2352x1568px:
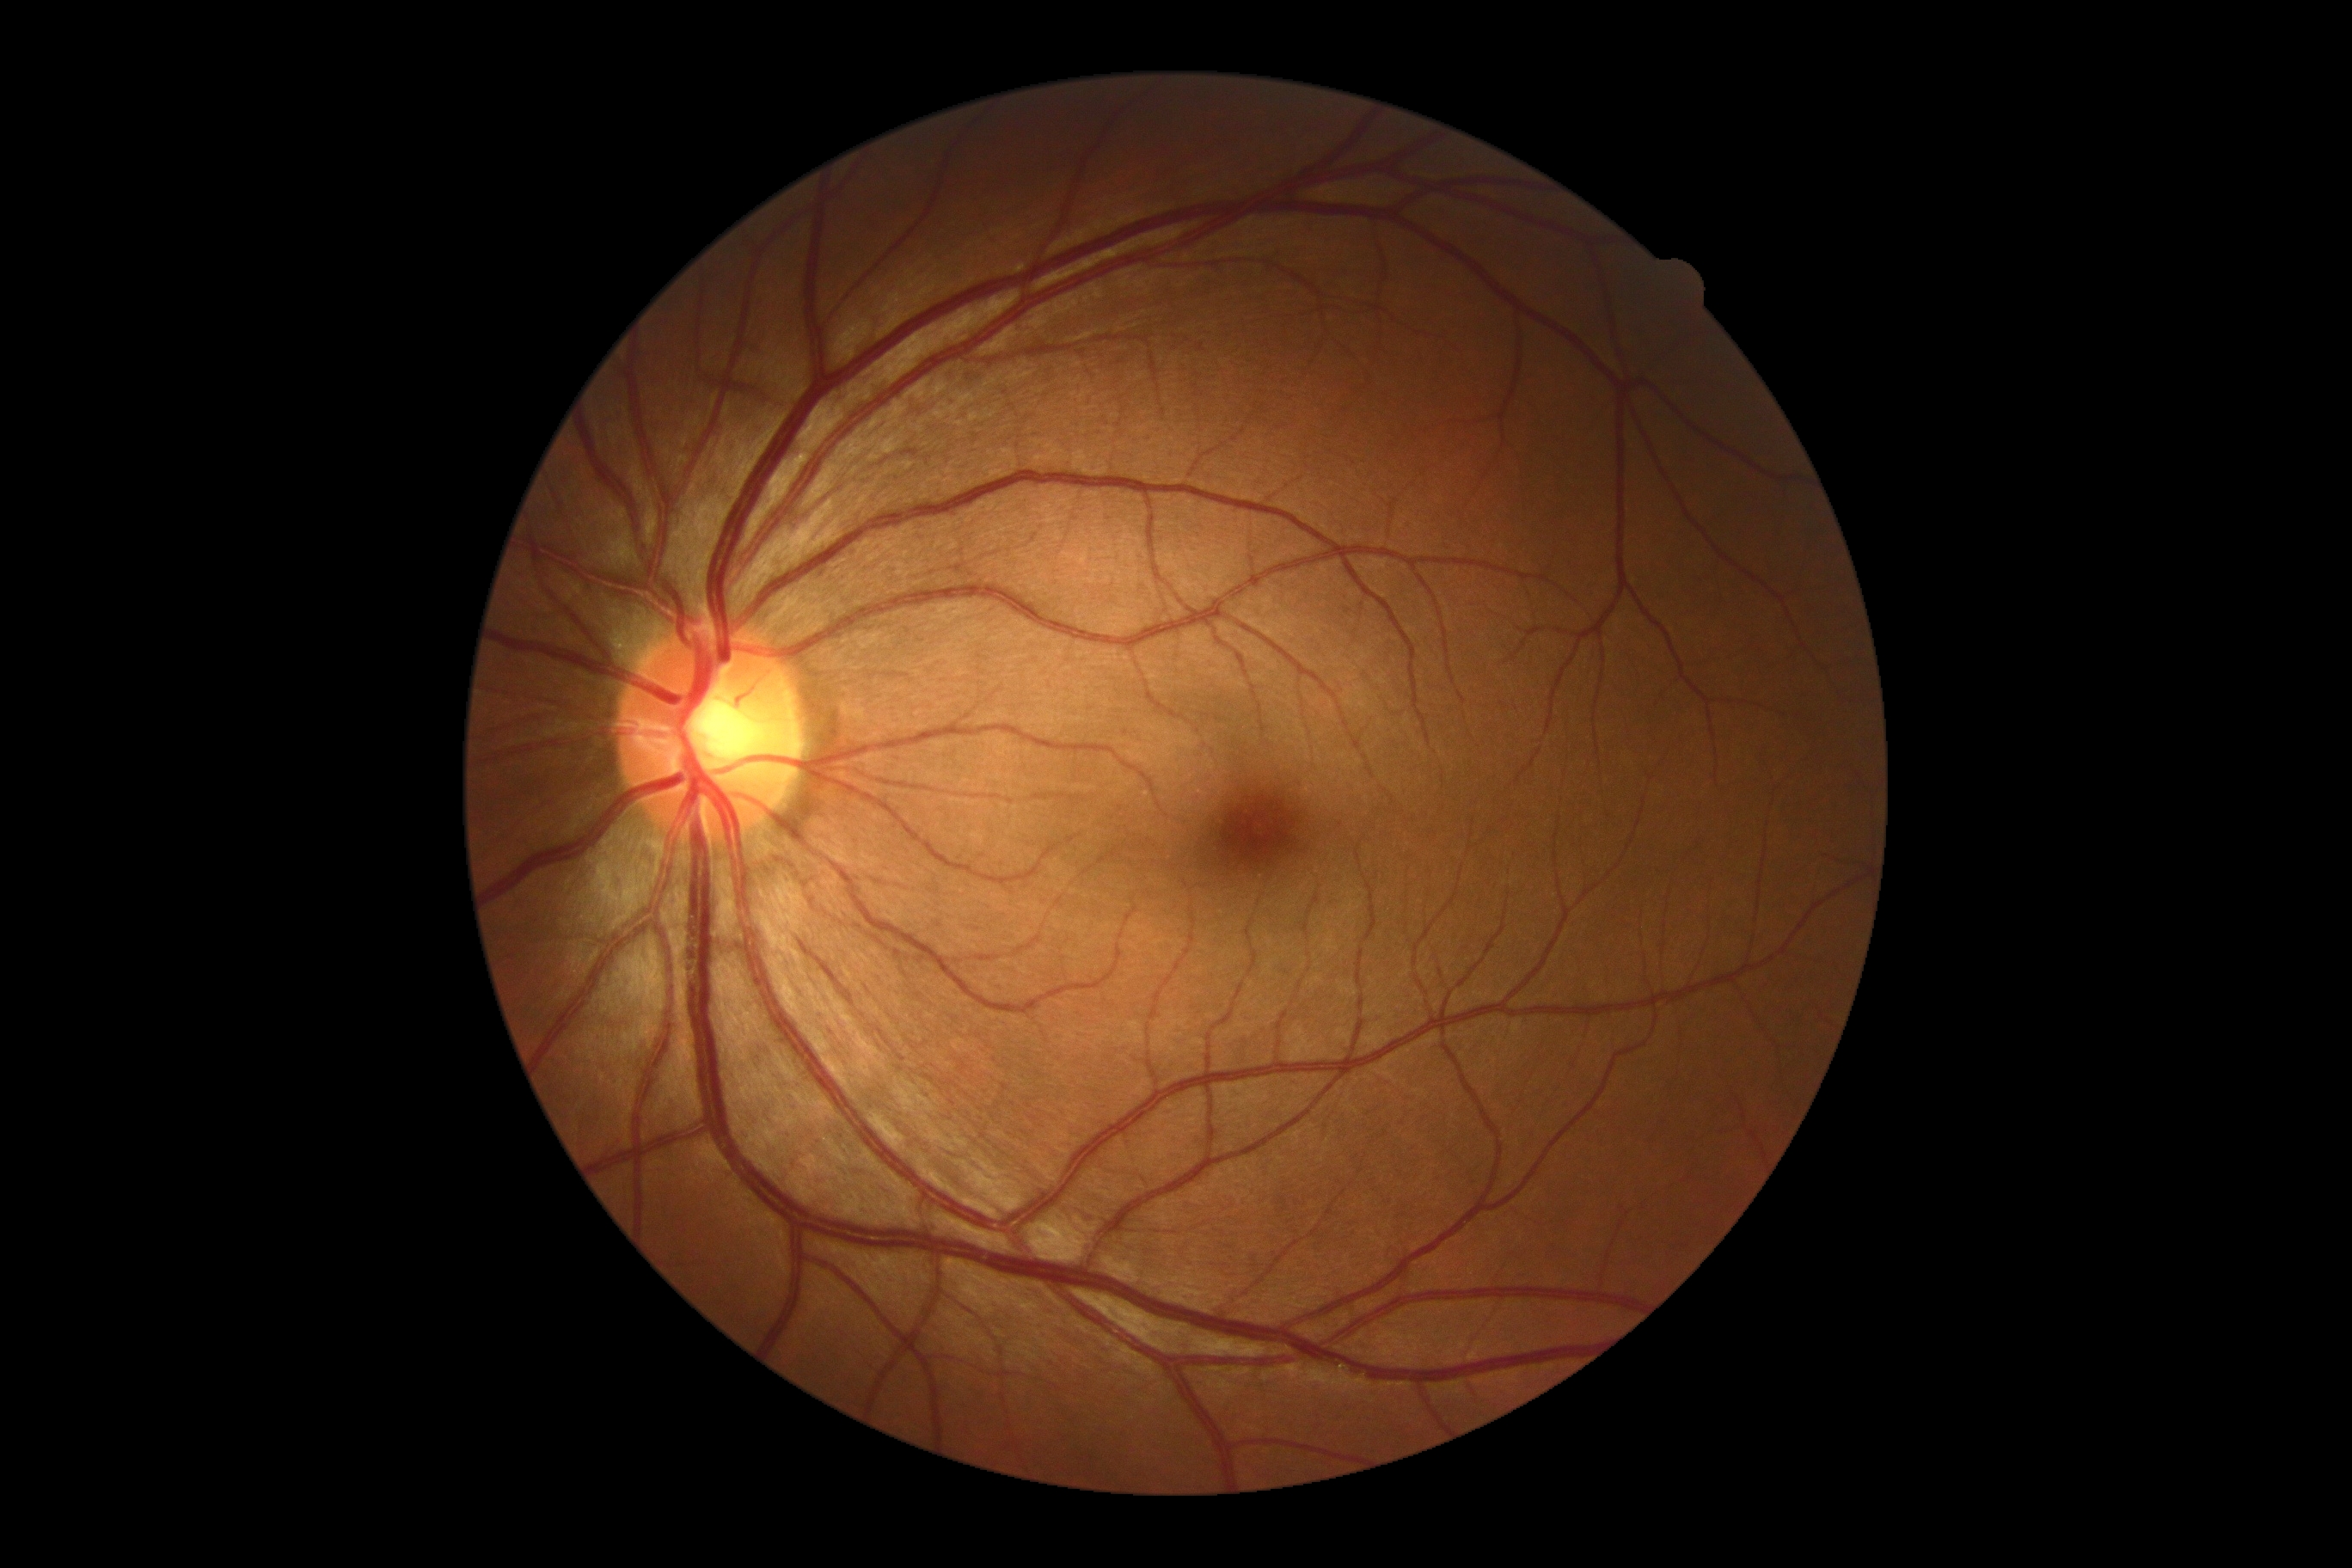   dr_grade: 0/4